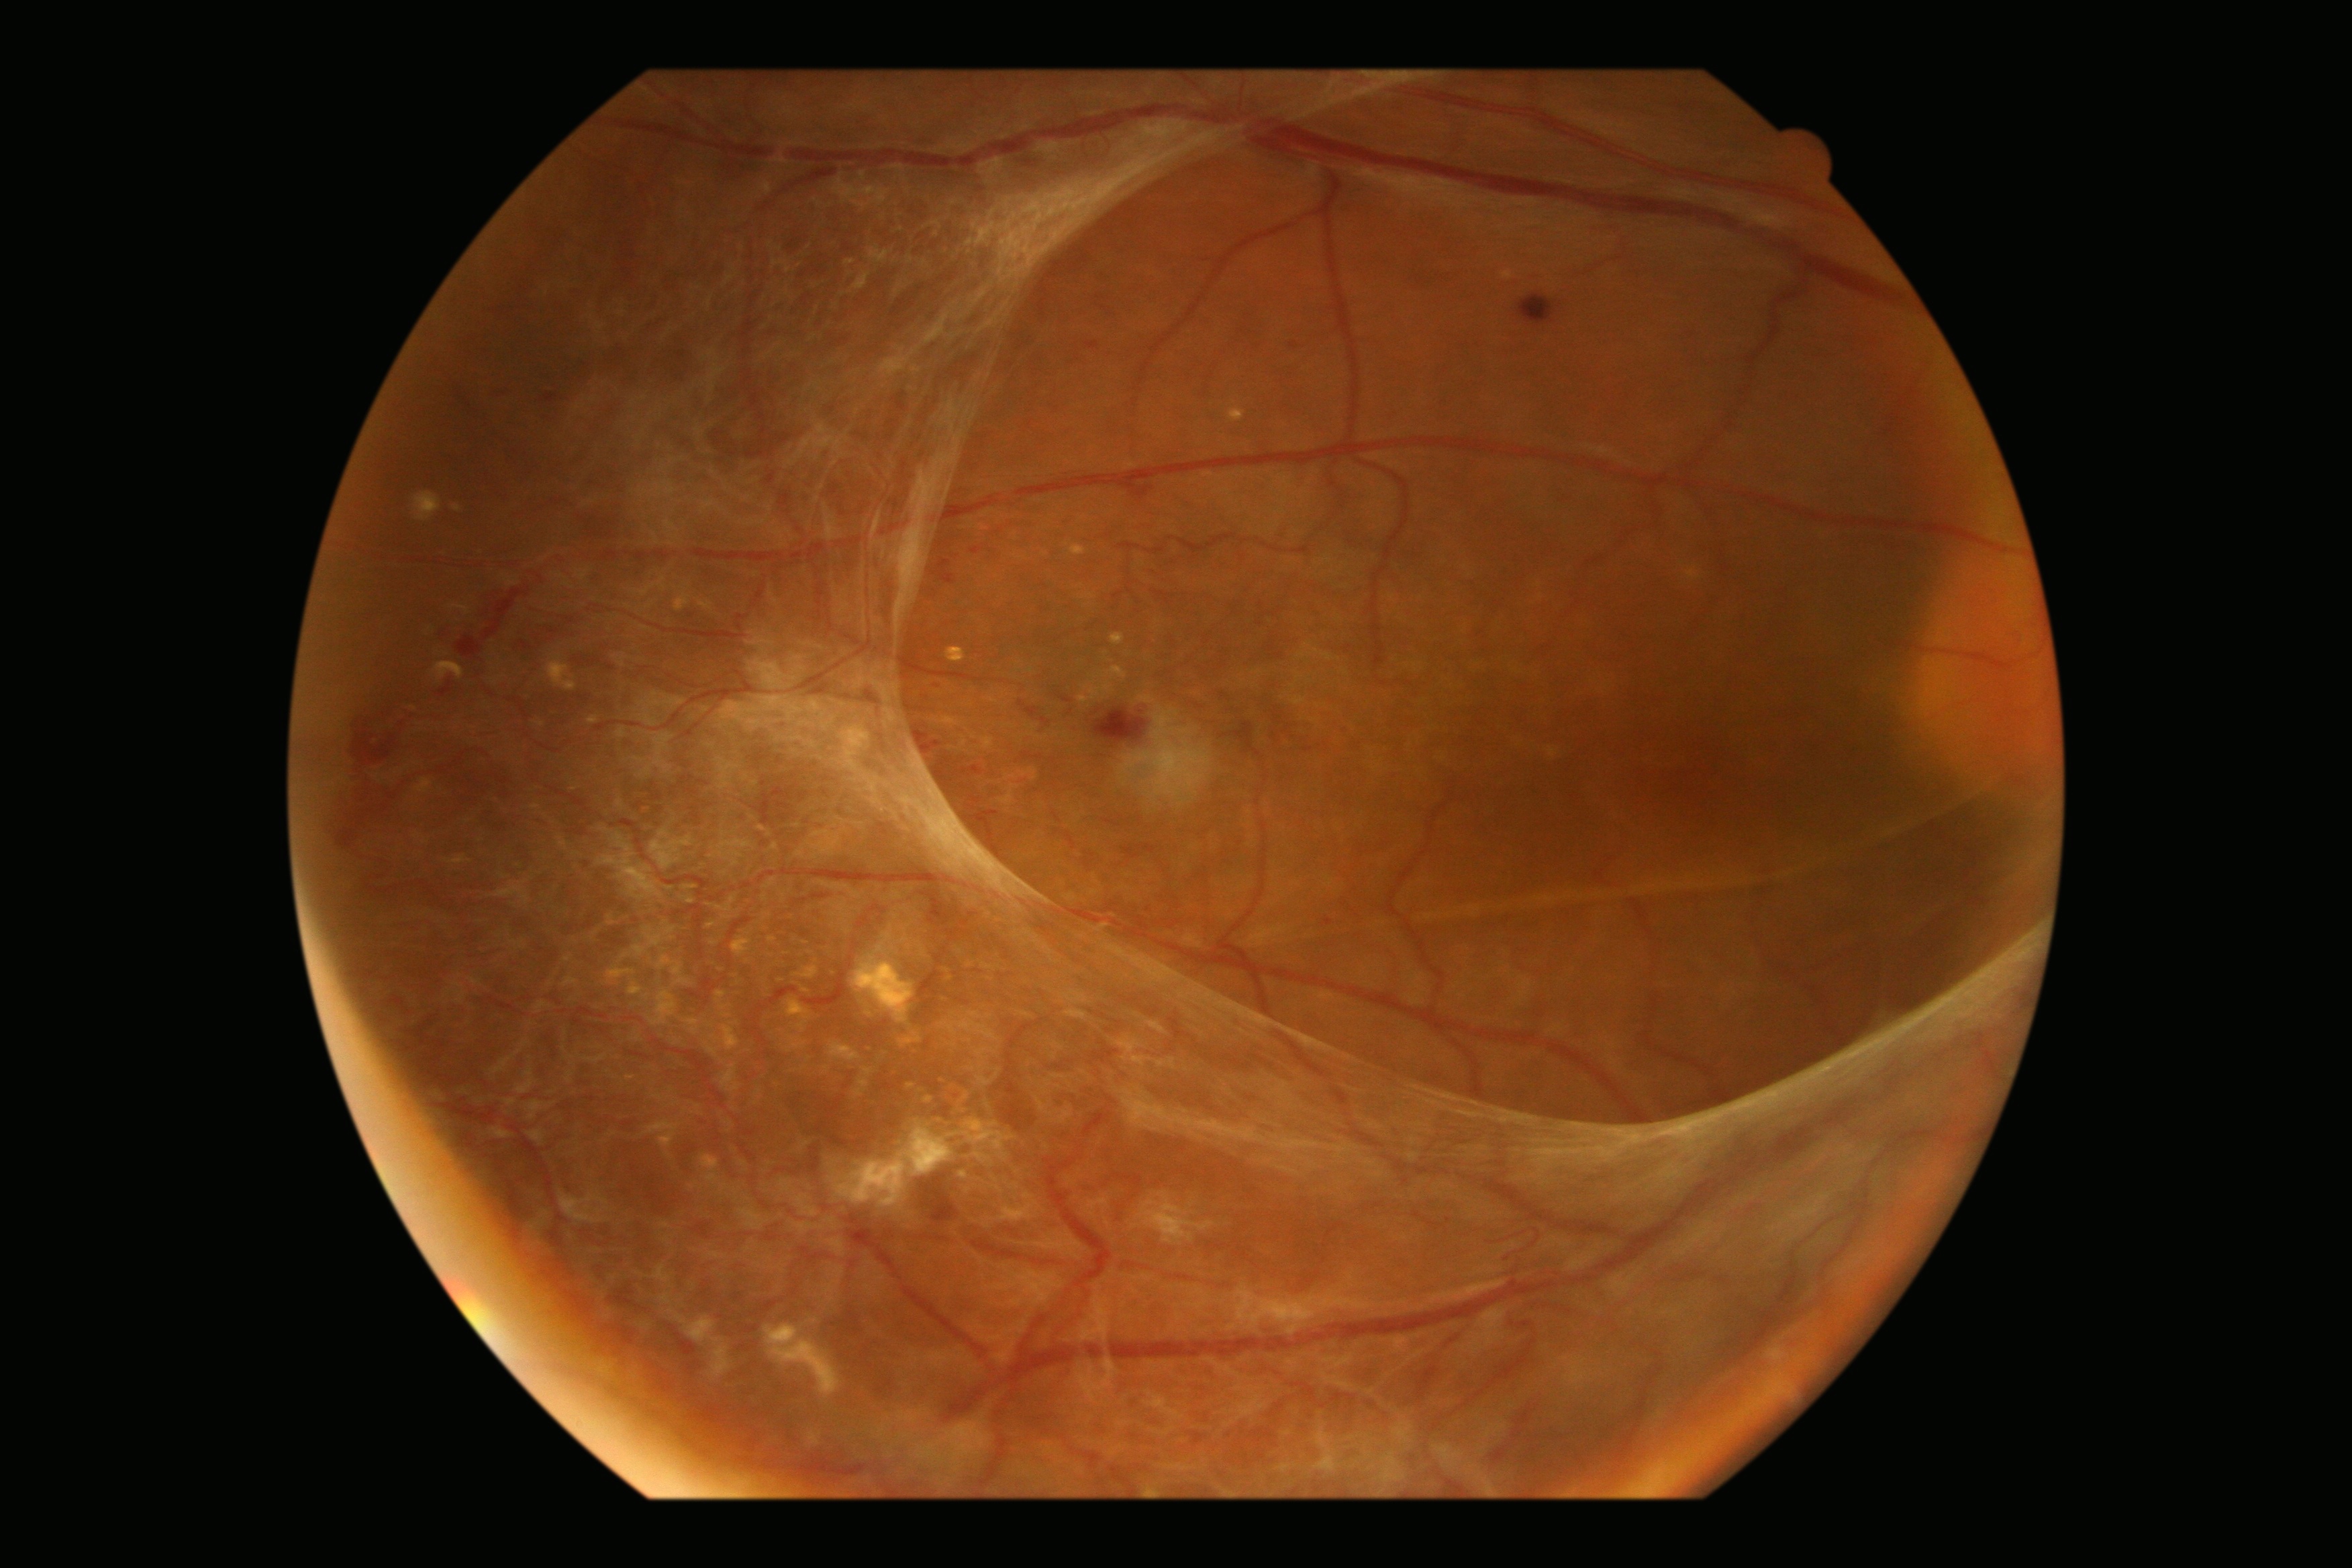

{
  "dr_grade": "grade 4 (PDR)",
  "dr_category": "proliferative diabetic retinopathy"
}